100° field of view (Phoenix ICON). 1240x1240px. Pediatric wide-field fundus photograph:
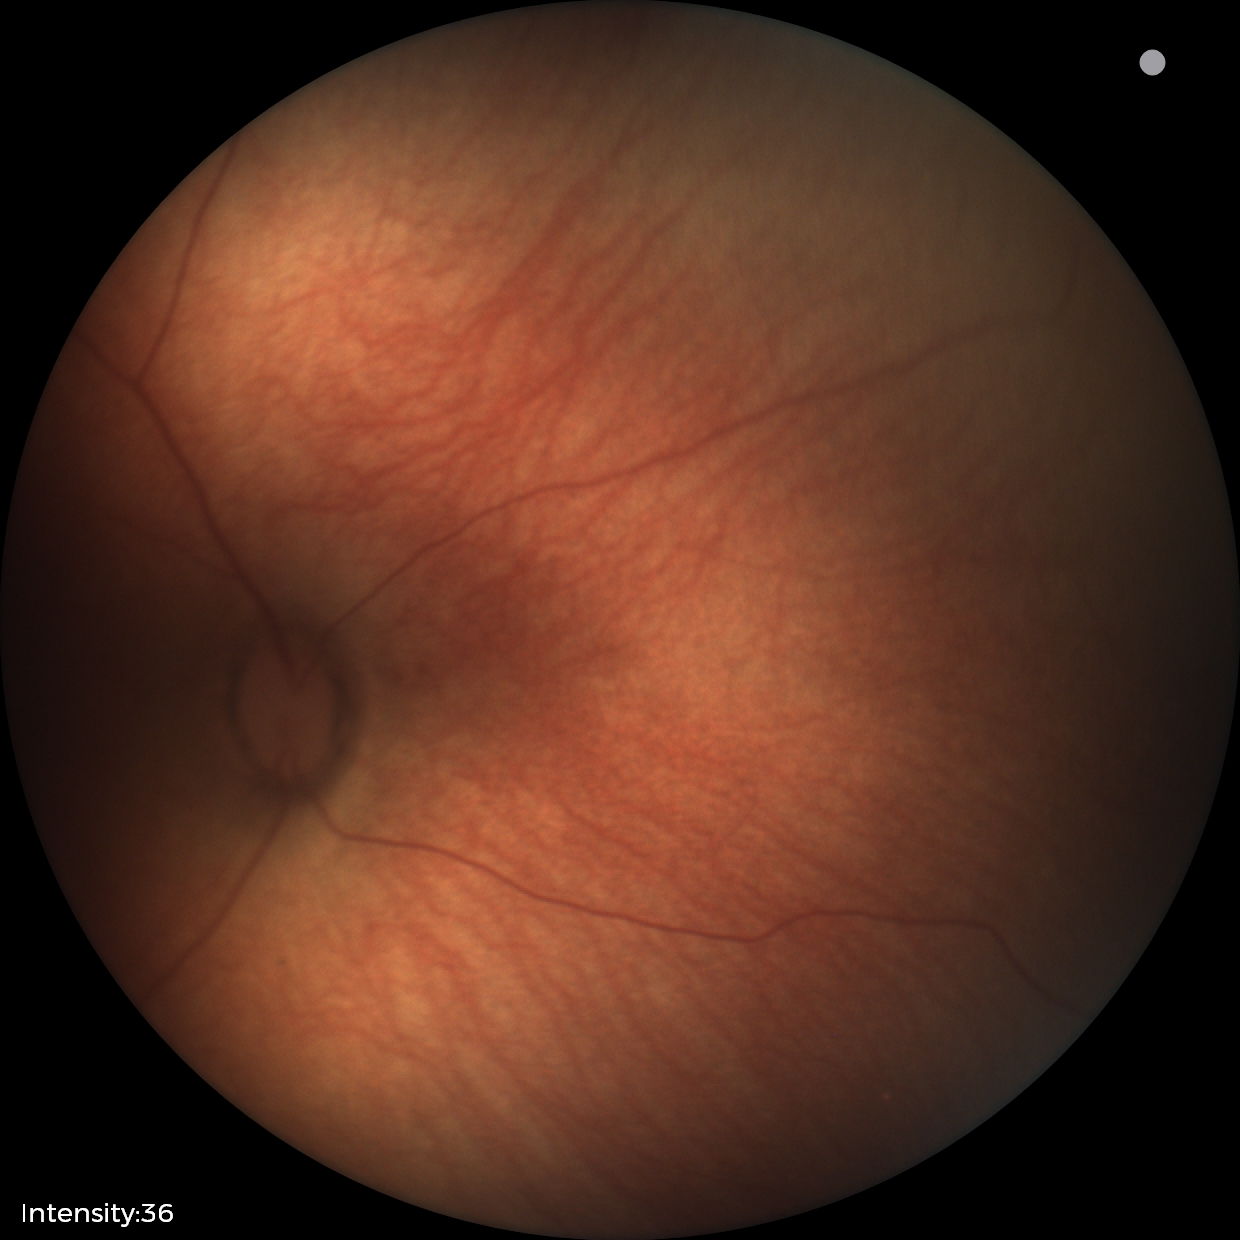
Examination with physiological retinal findings.